Wide-field fundus image from infant ROP screening: 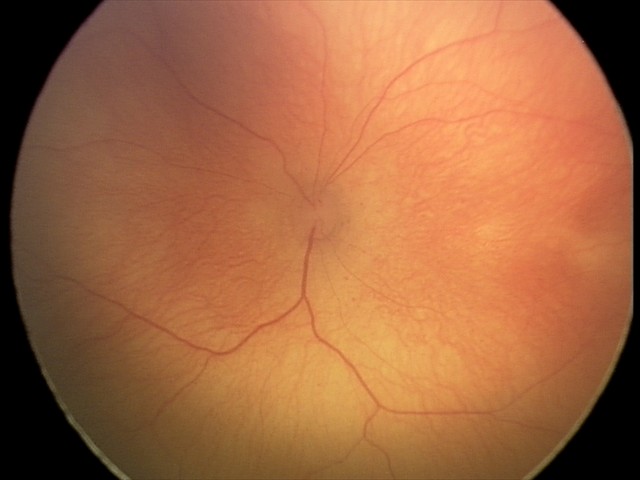
Finding = retinopathy of prematurity stage 2.